Retinal fundus photograph.
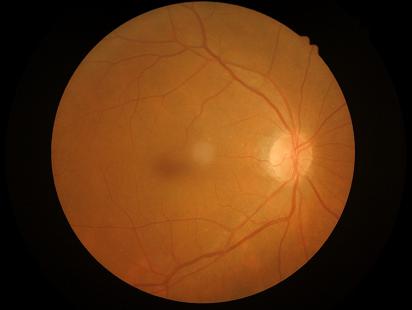

Overall image quality is good. Good dynamic range.